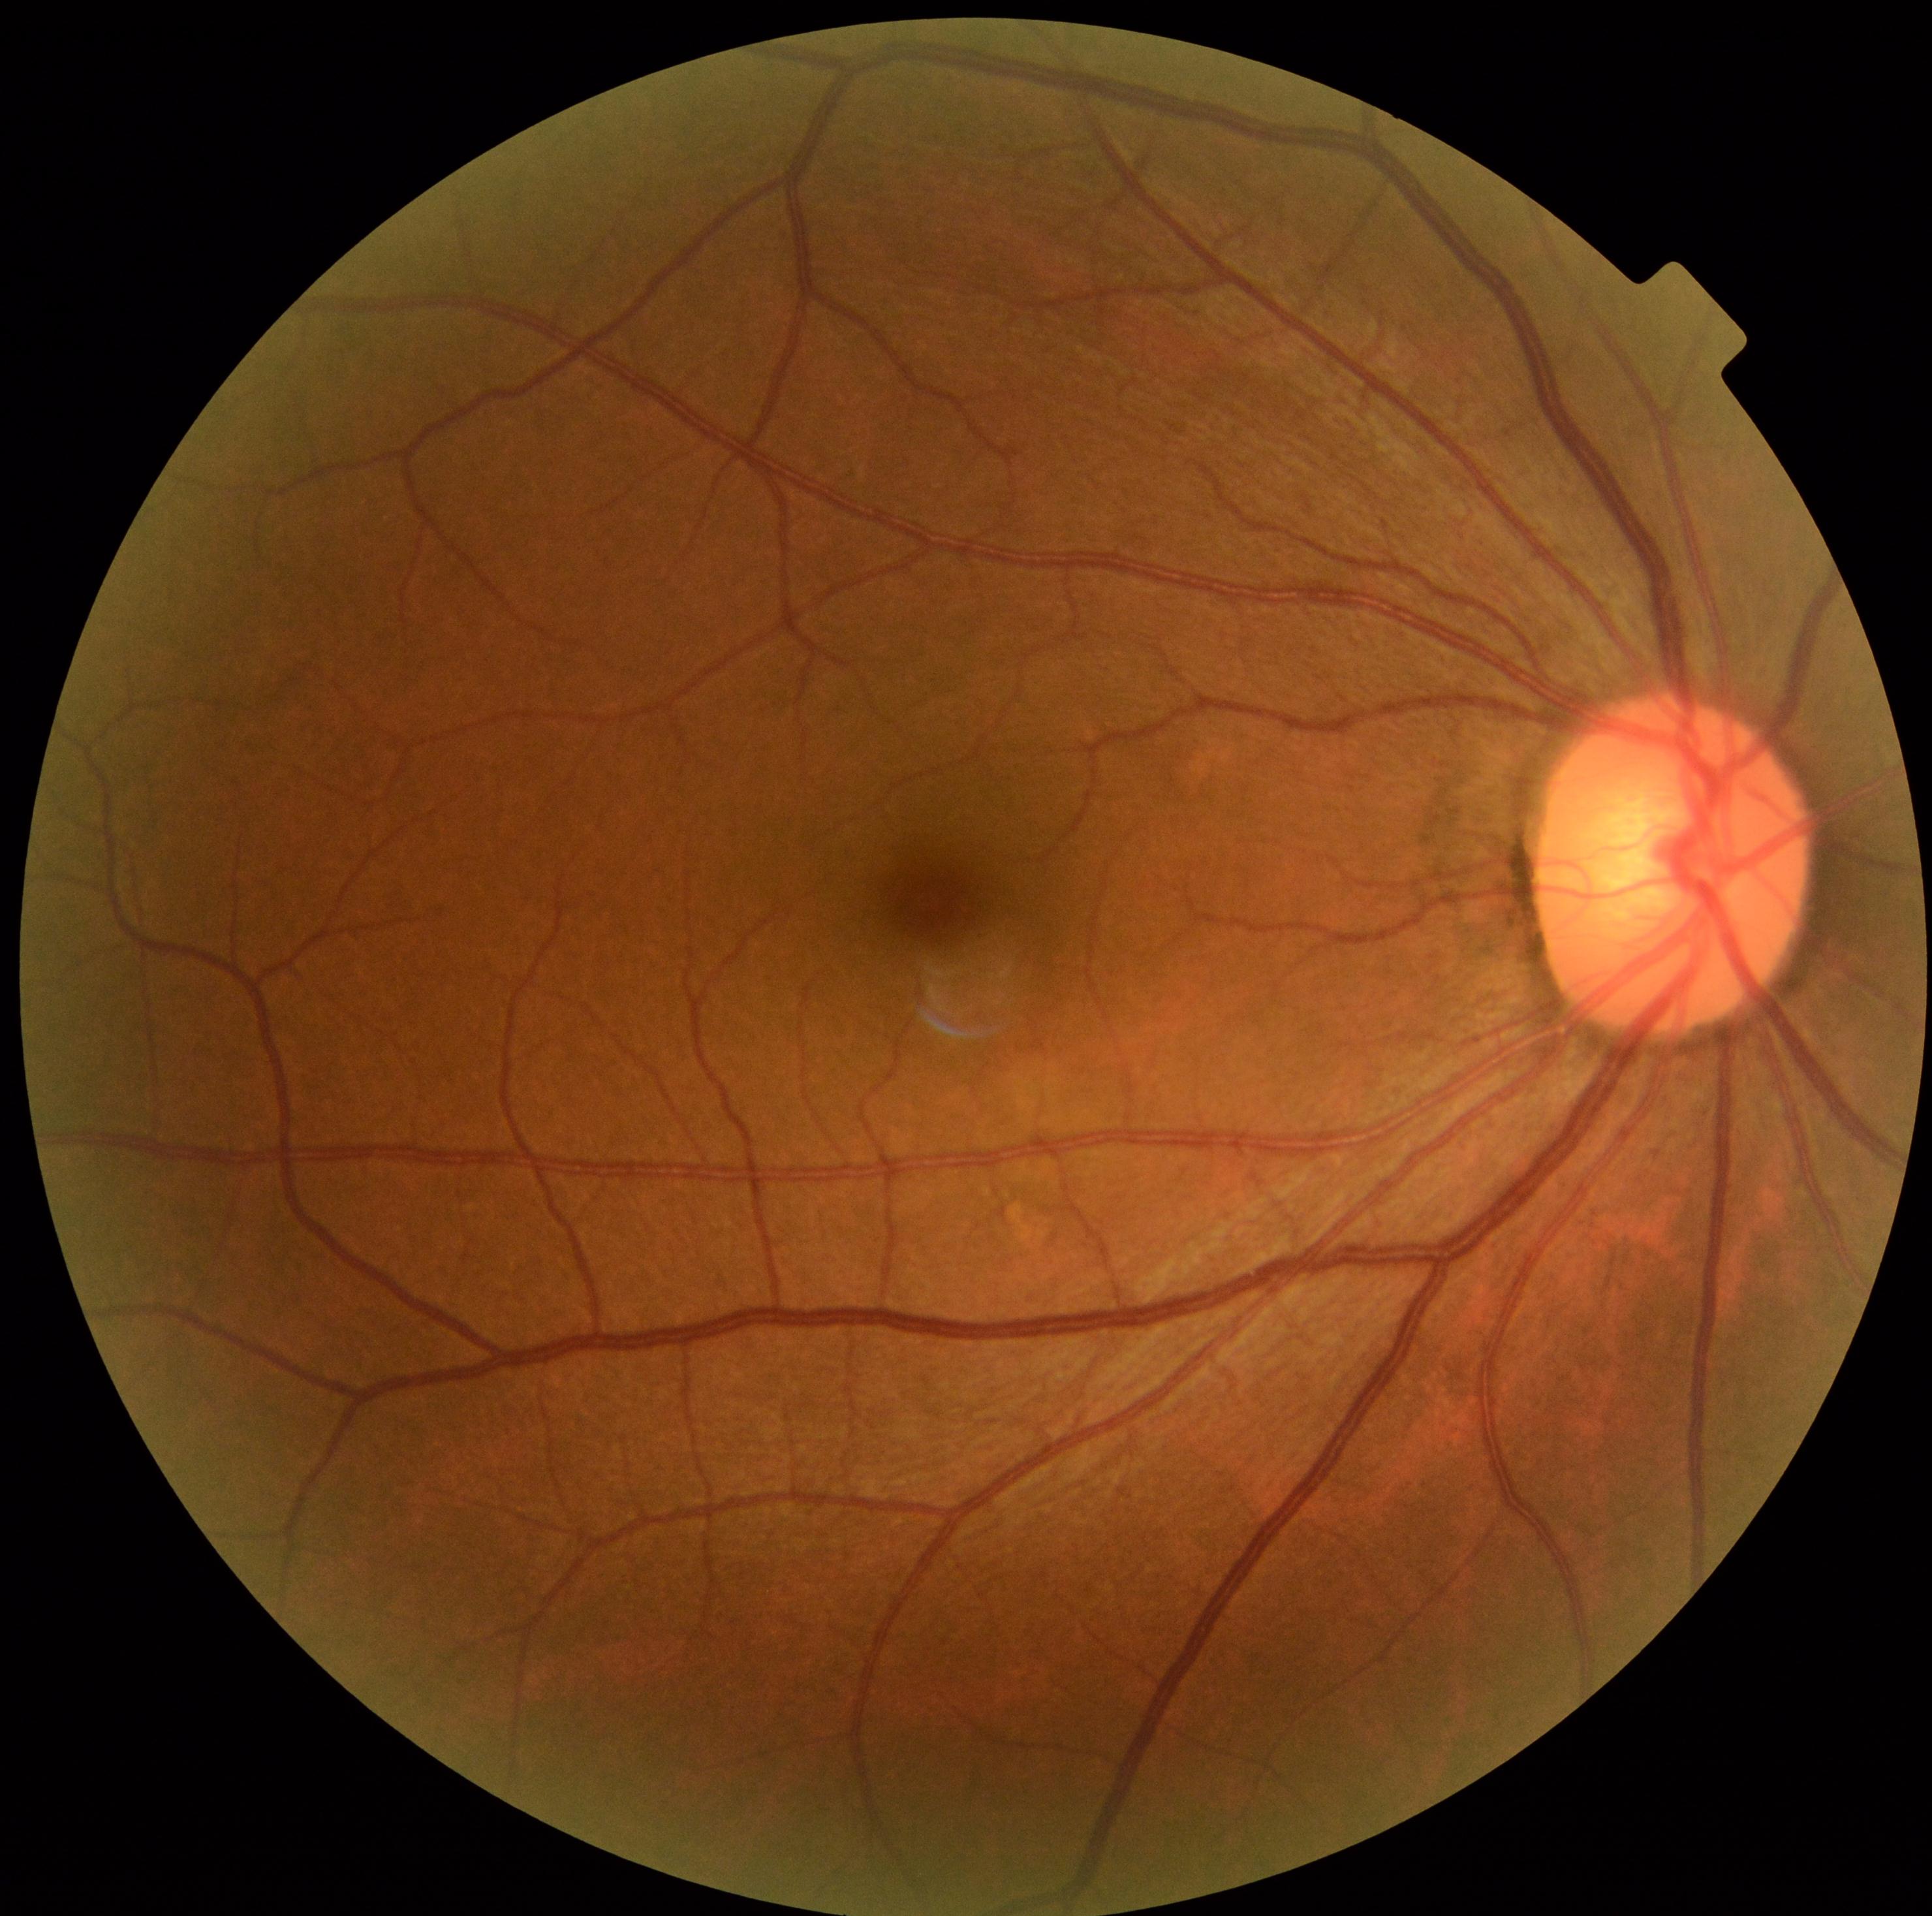 Diabetic retinopathy (DR): grade 0 (no apparent retinopathy) — no visible signs of diabetic retinopathy.